Wide-field fundus photograph of an infant · 130° field of view (Natus RetCam Envision):
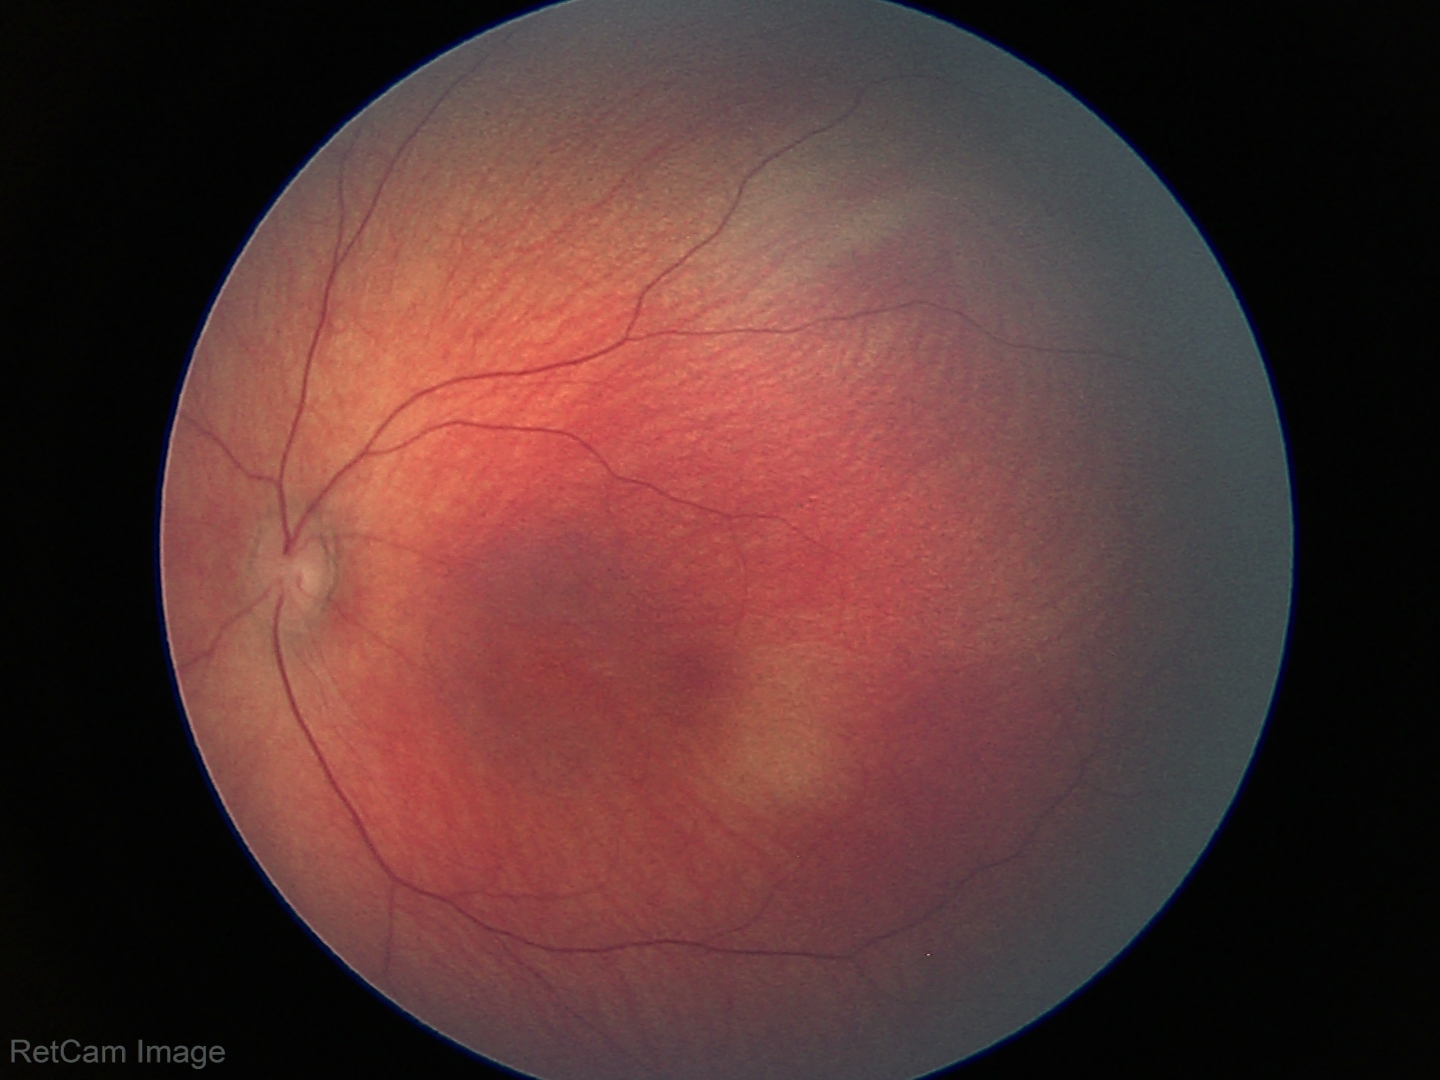 Screening examination diagnosed as physiological.